Infant wide-field fundus photograph; captured with the Clarity RetCam 3 (130° field of view): 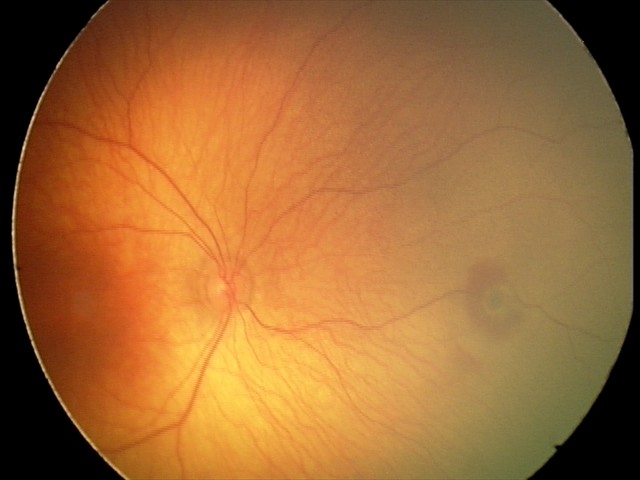
Screening examination consistent with retinal hemorrhages.